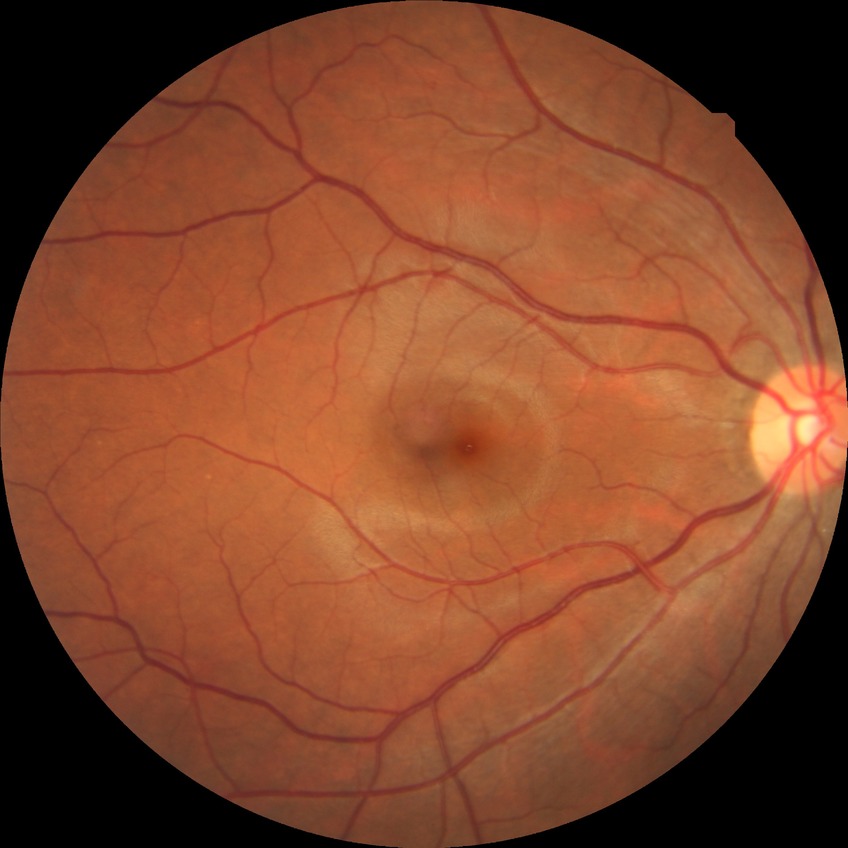 Diabetic retinopathy (DR) is no diabetic retinopathy (NDR).